848 by 848 pixels, without pupil dilation.
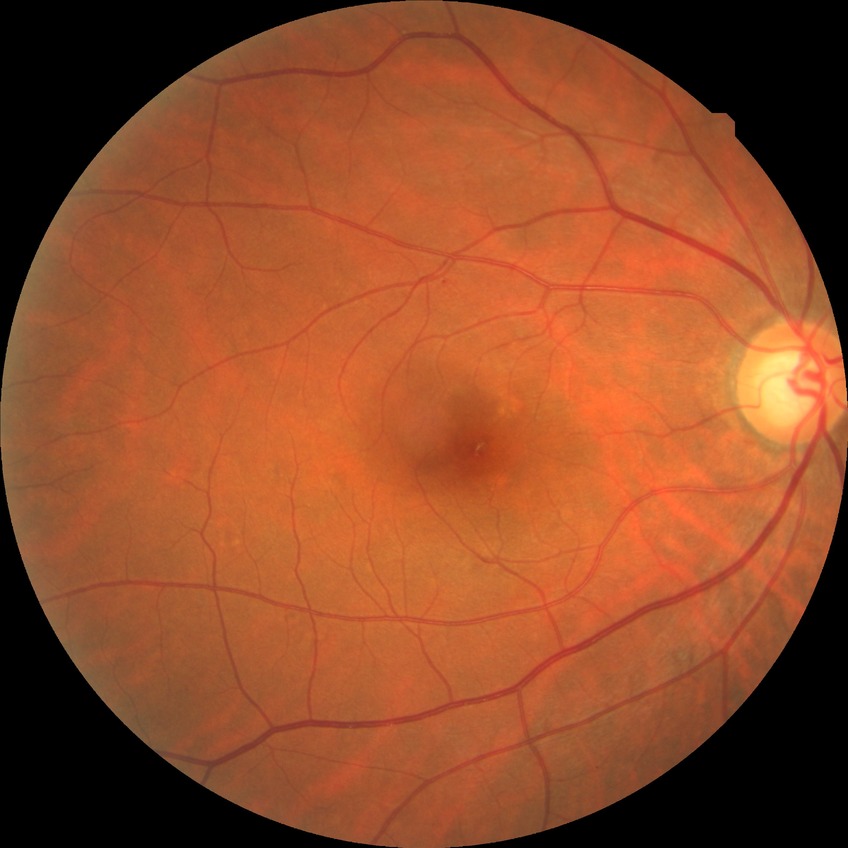

Diabetic retinopathy (DR): NDR (no diabetic retinopathy).